2352x1568px:
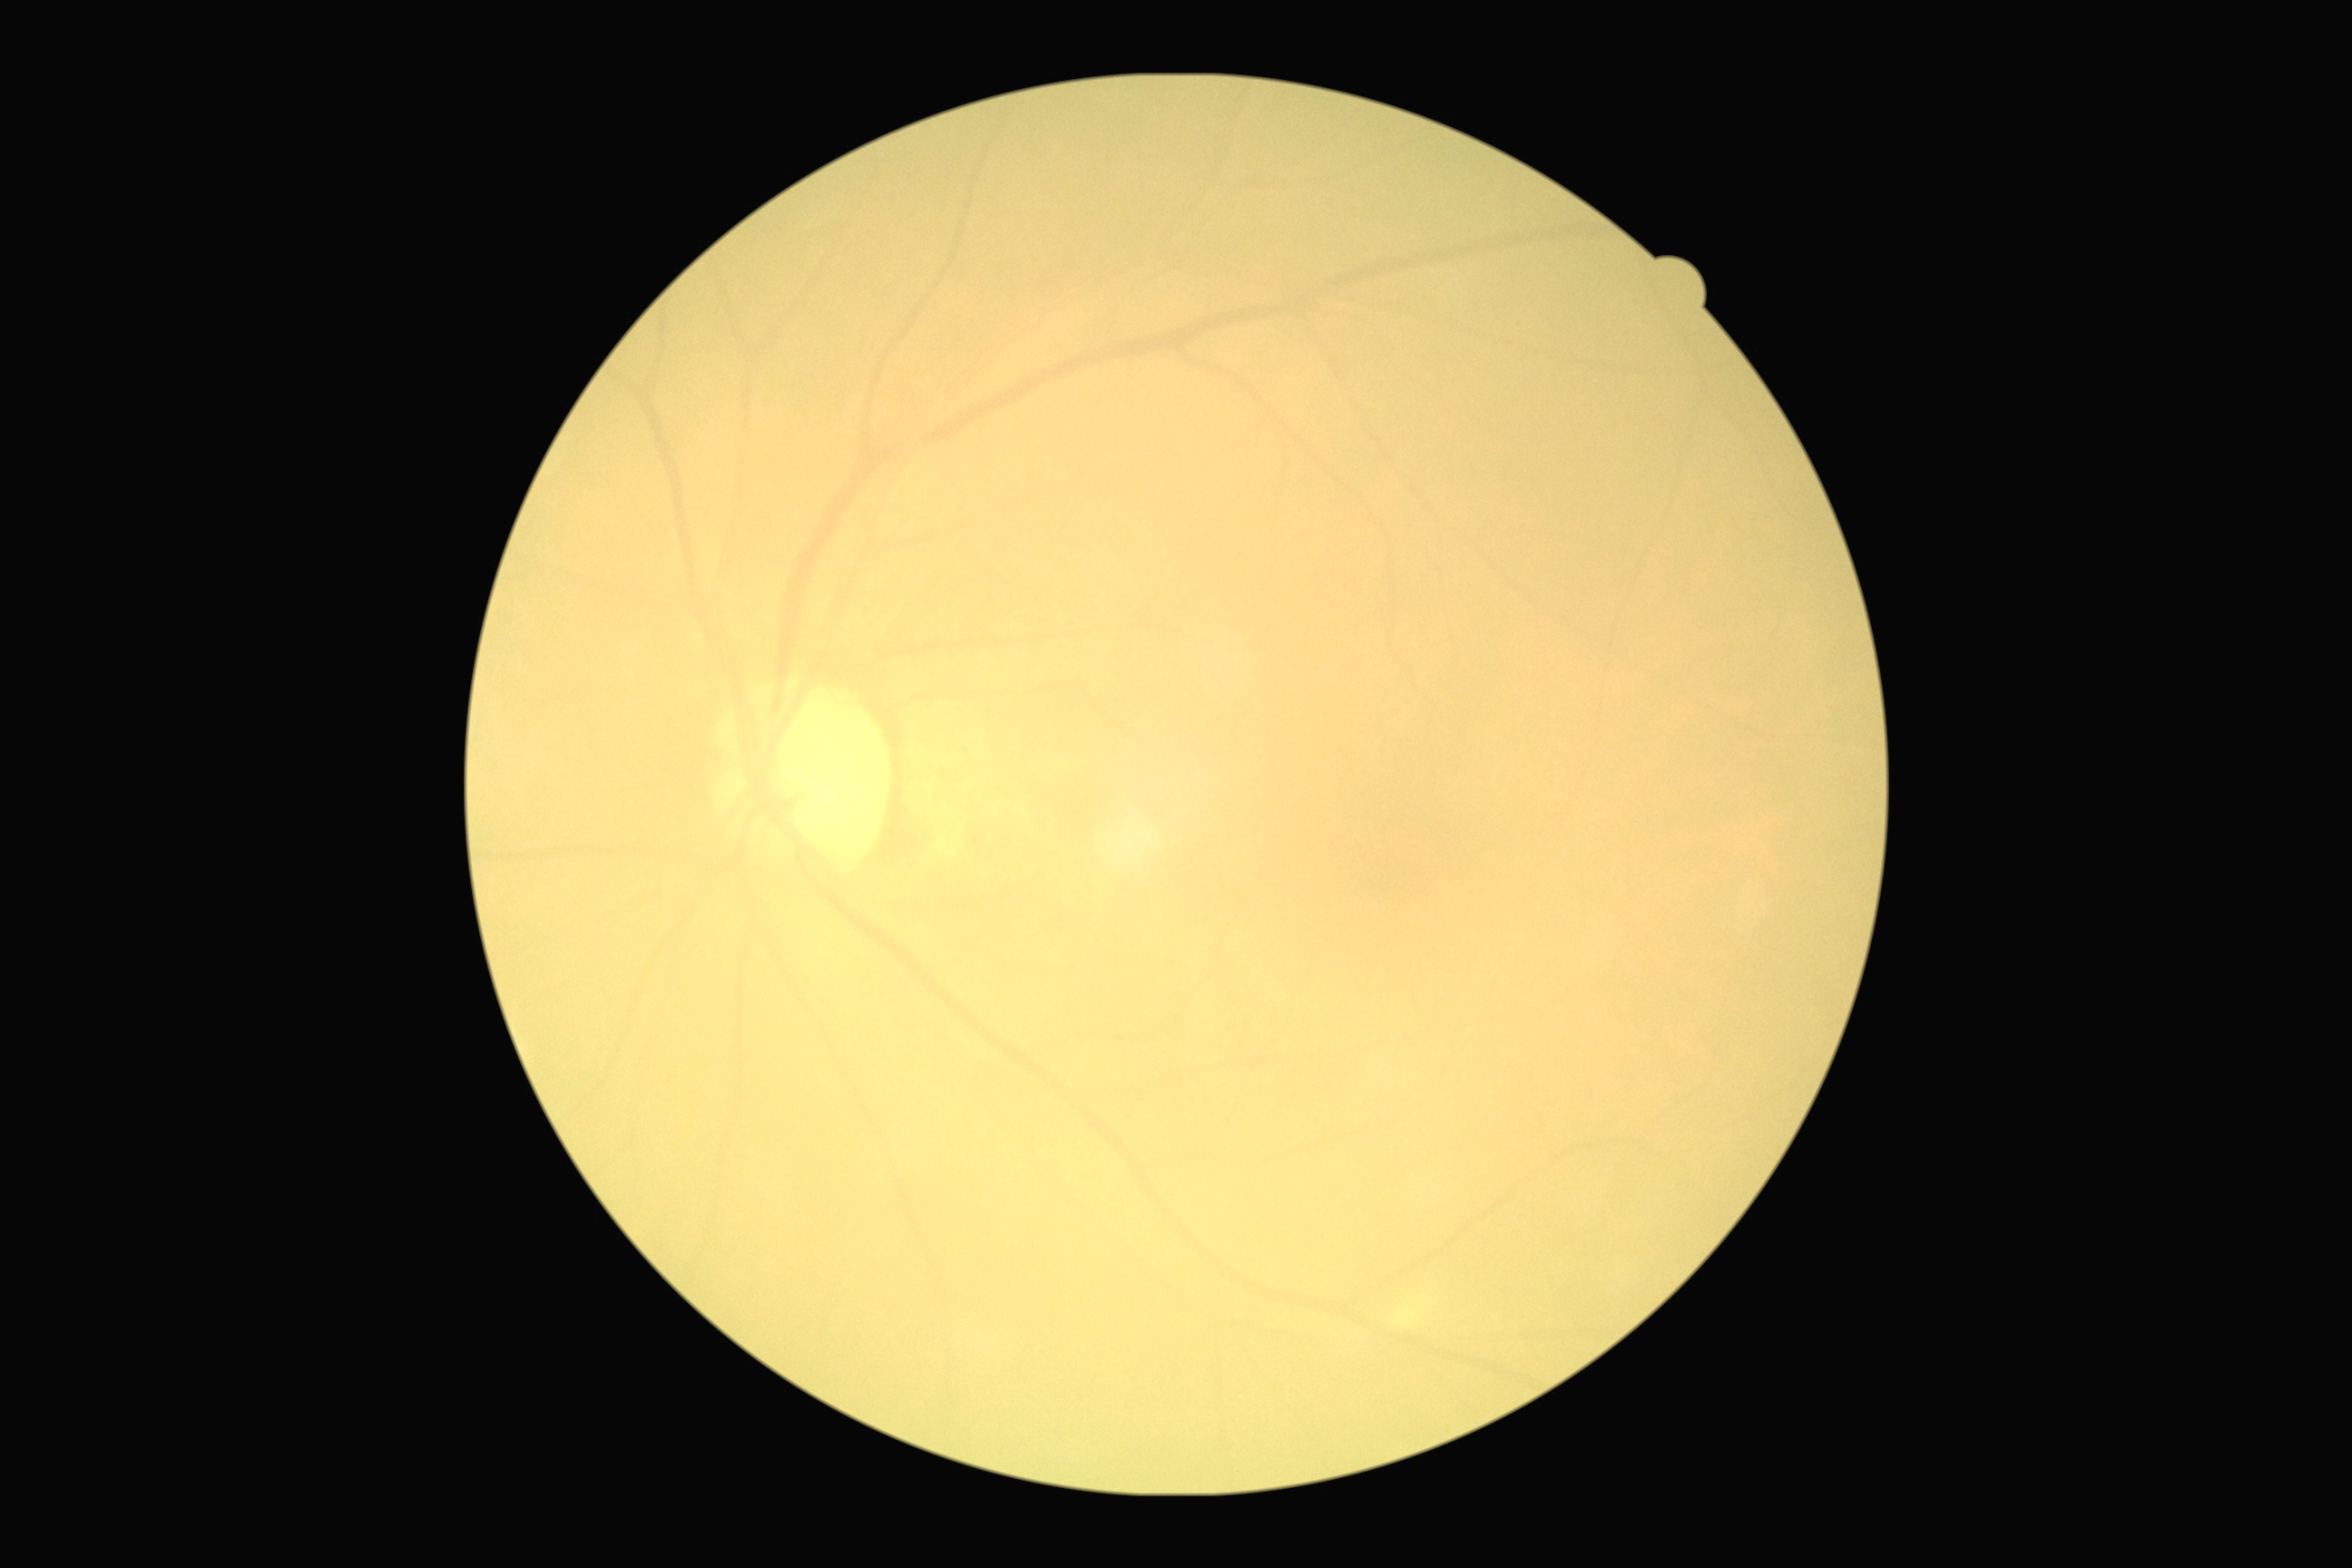

Retinopathy grade: no apparent retinopathy (0).